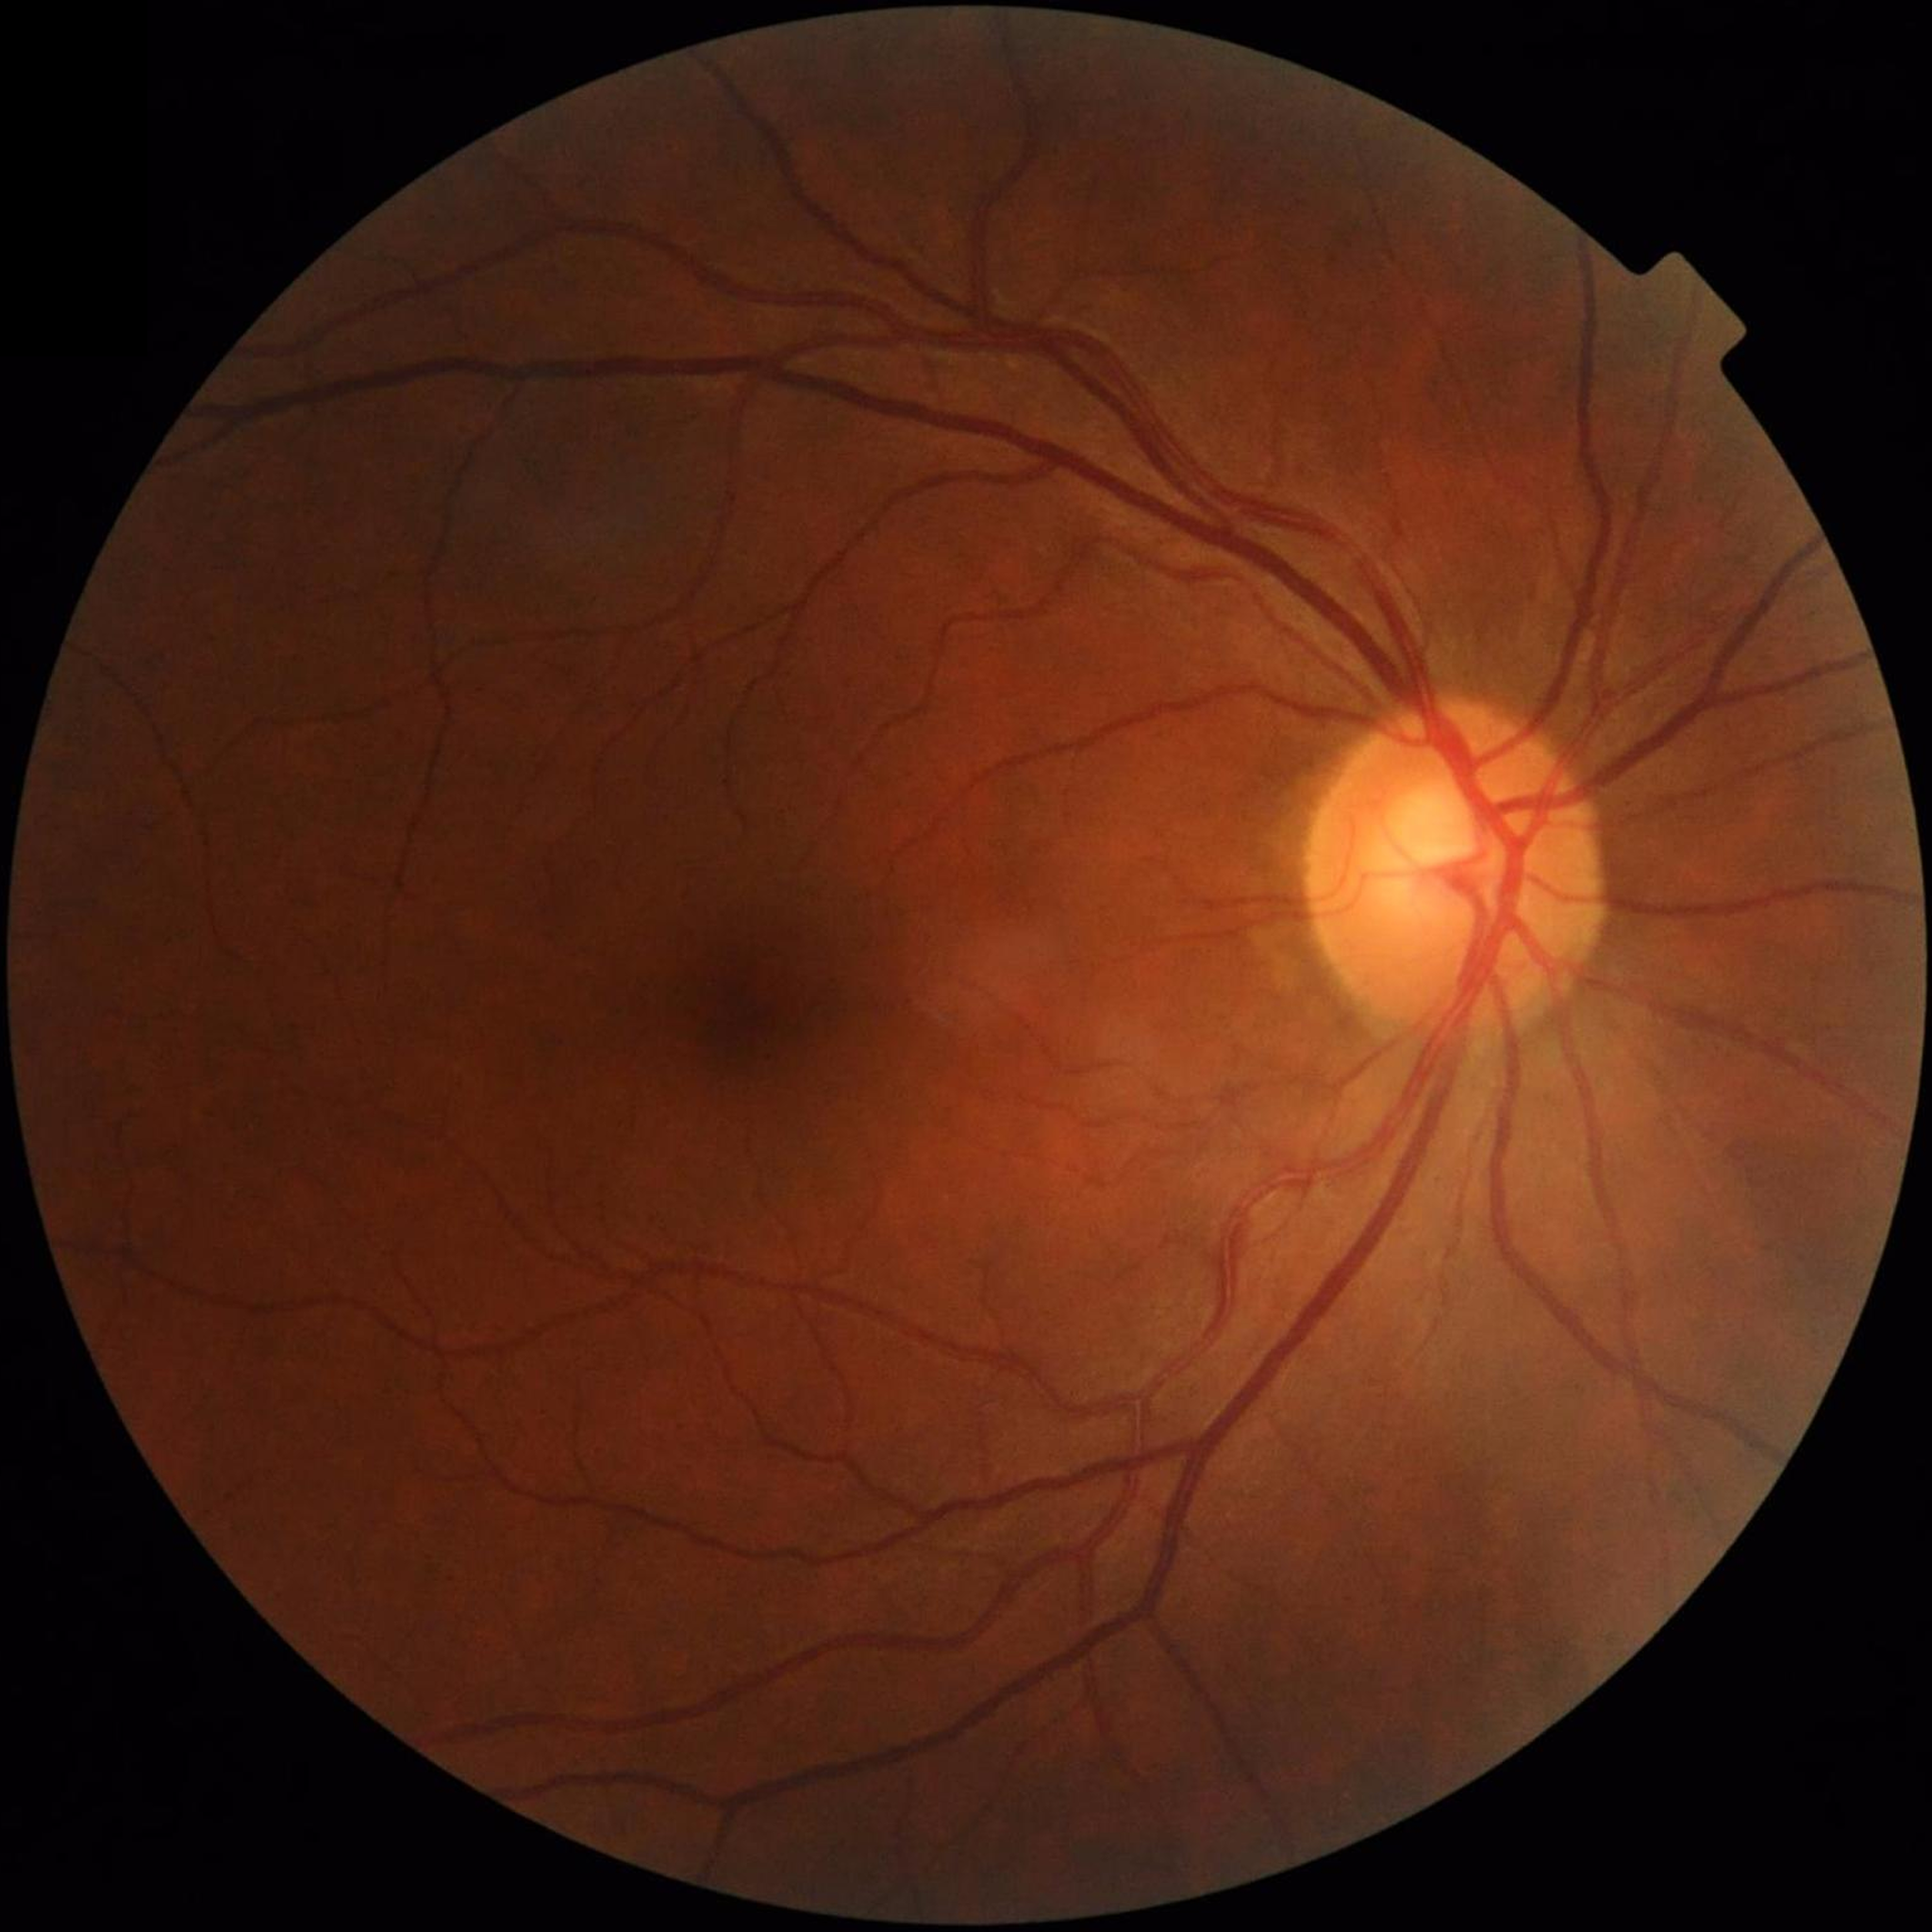
Impression: no AMD, DR, or glaucomatous findings